Infant wide-field fundus photograph:
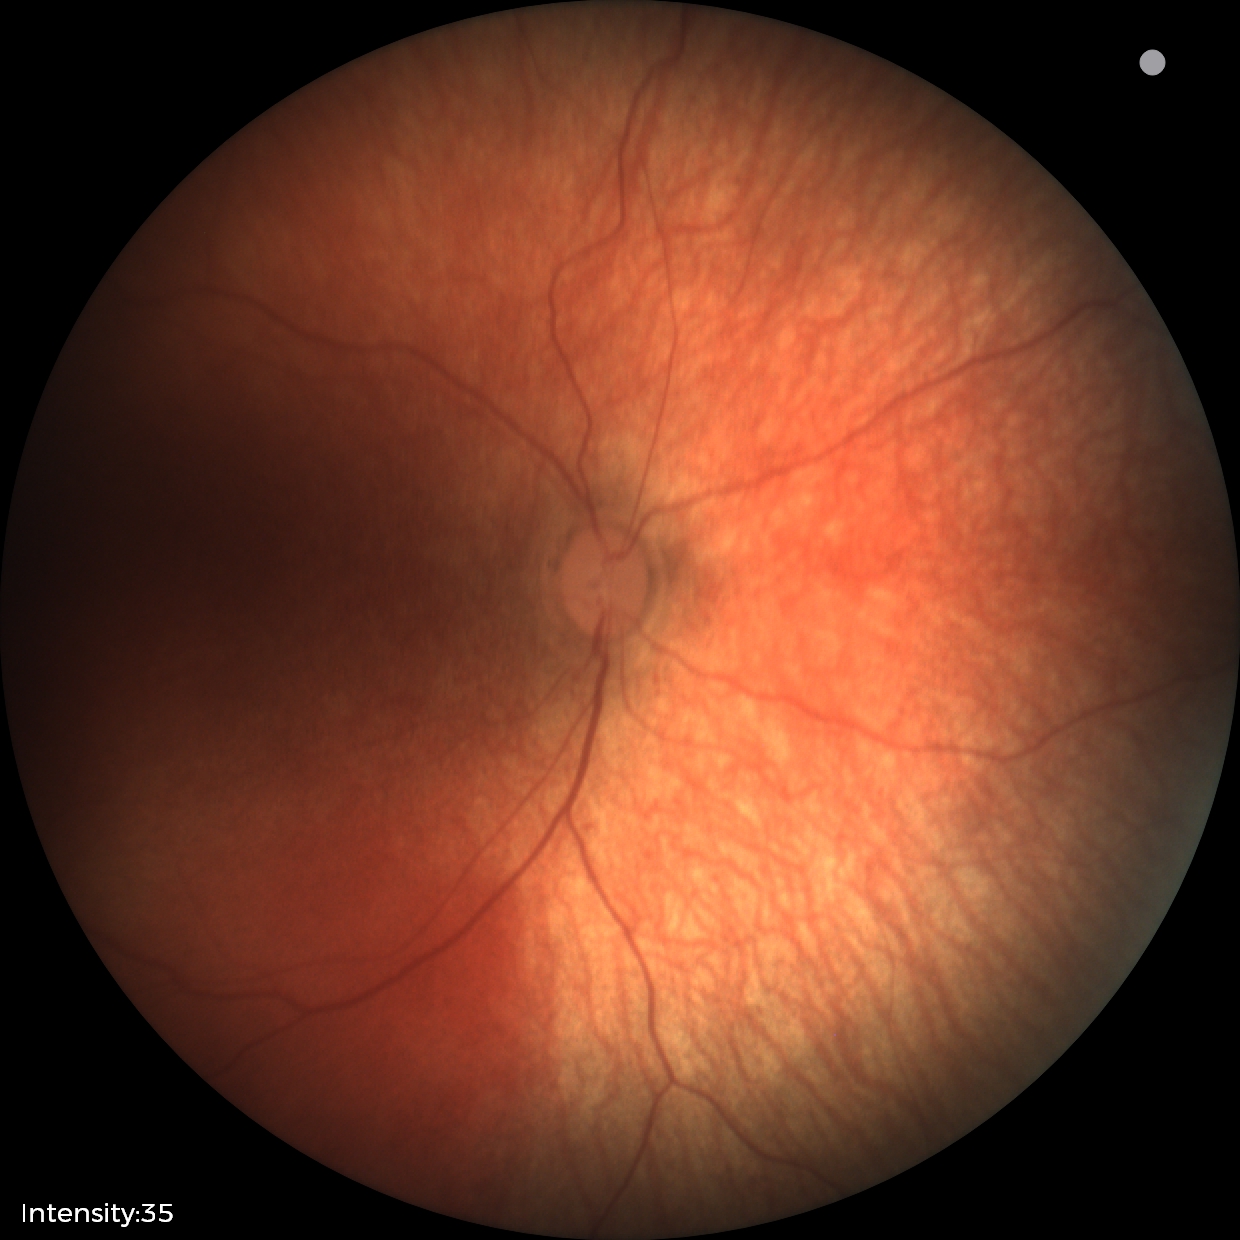
Physiological retinal appearance for postconceptual age.